2048x1536
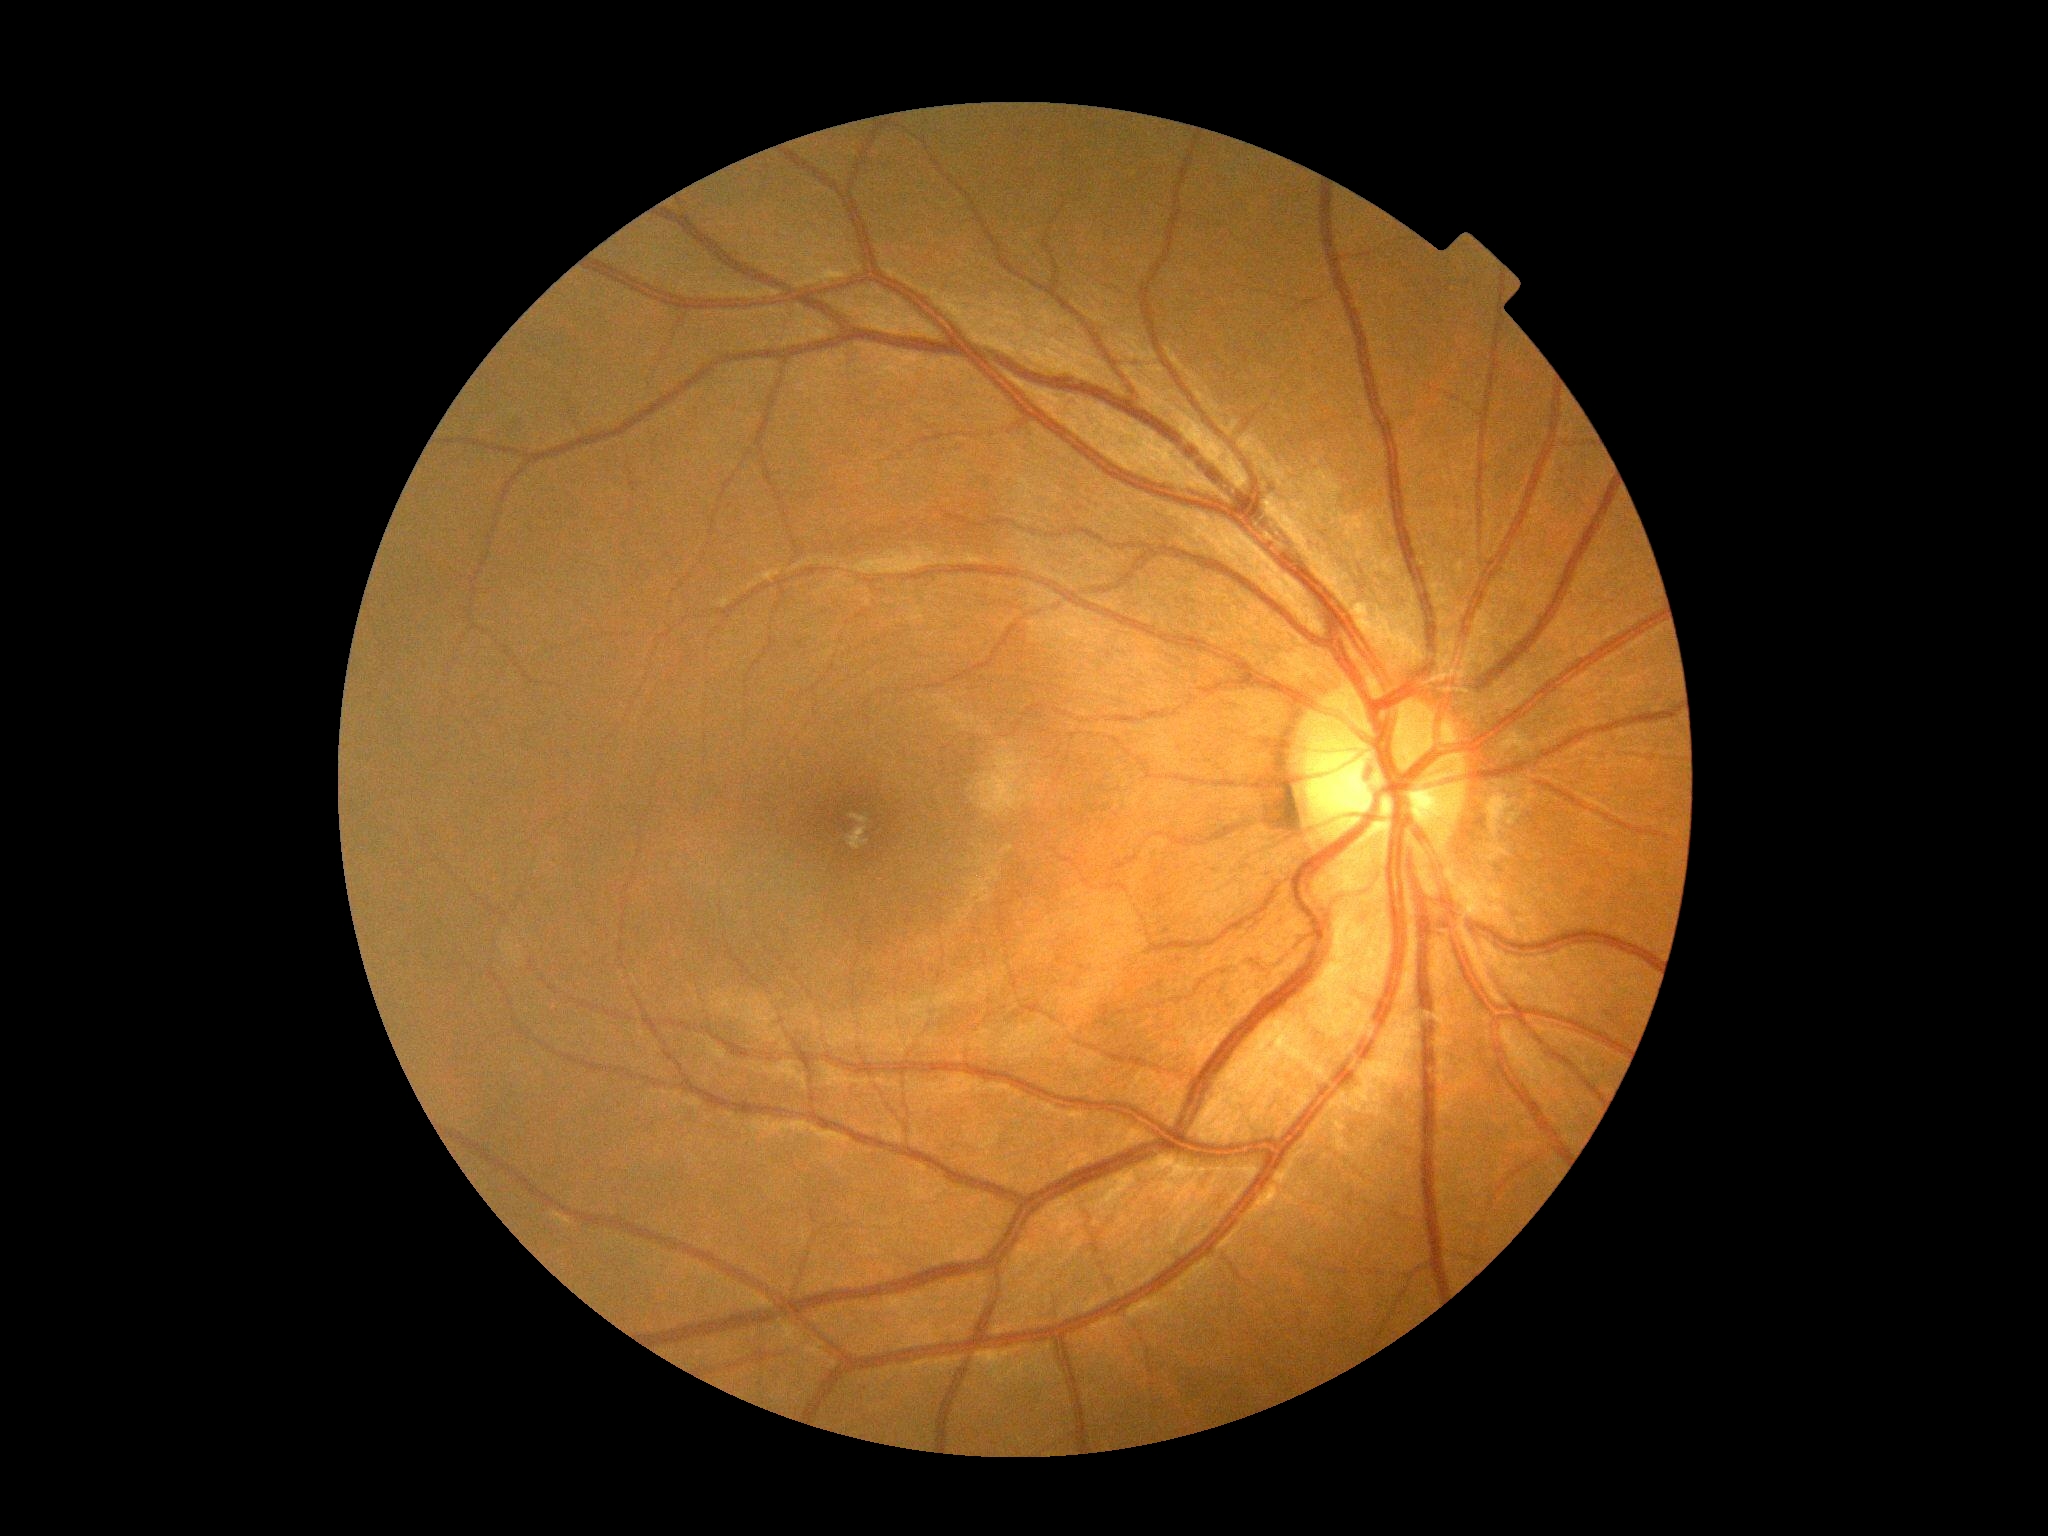
DR: no apparent diabetic retinopathy (grade 0).